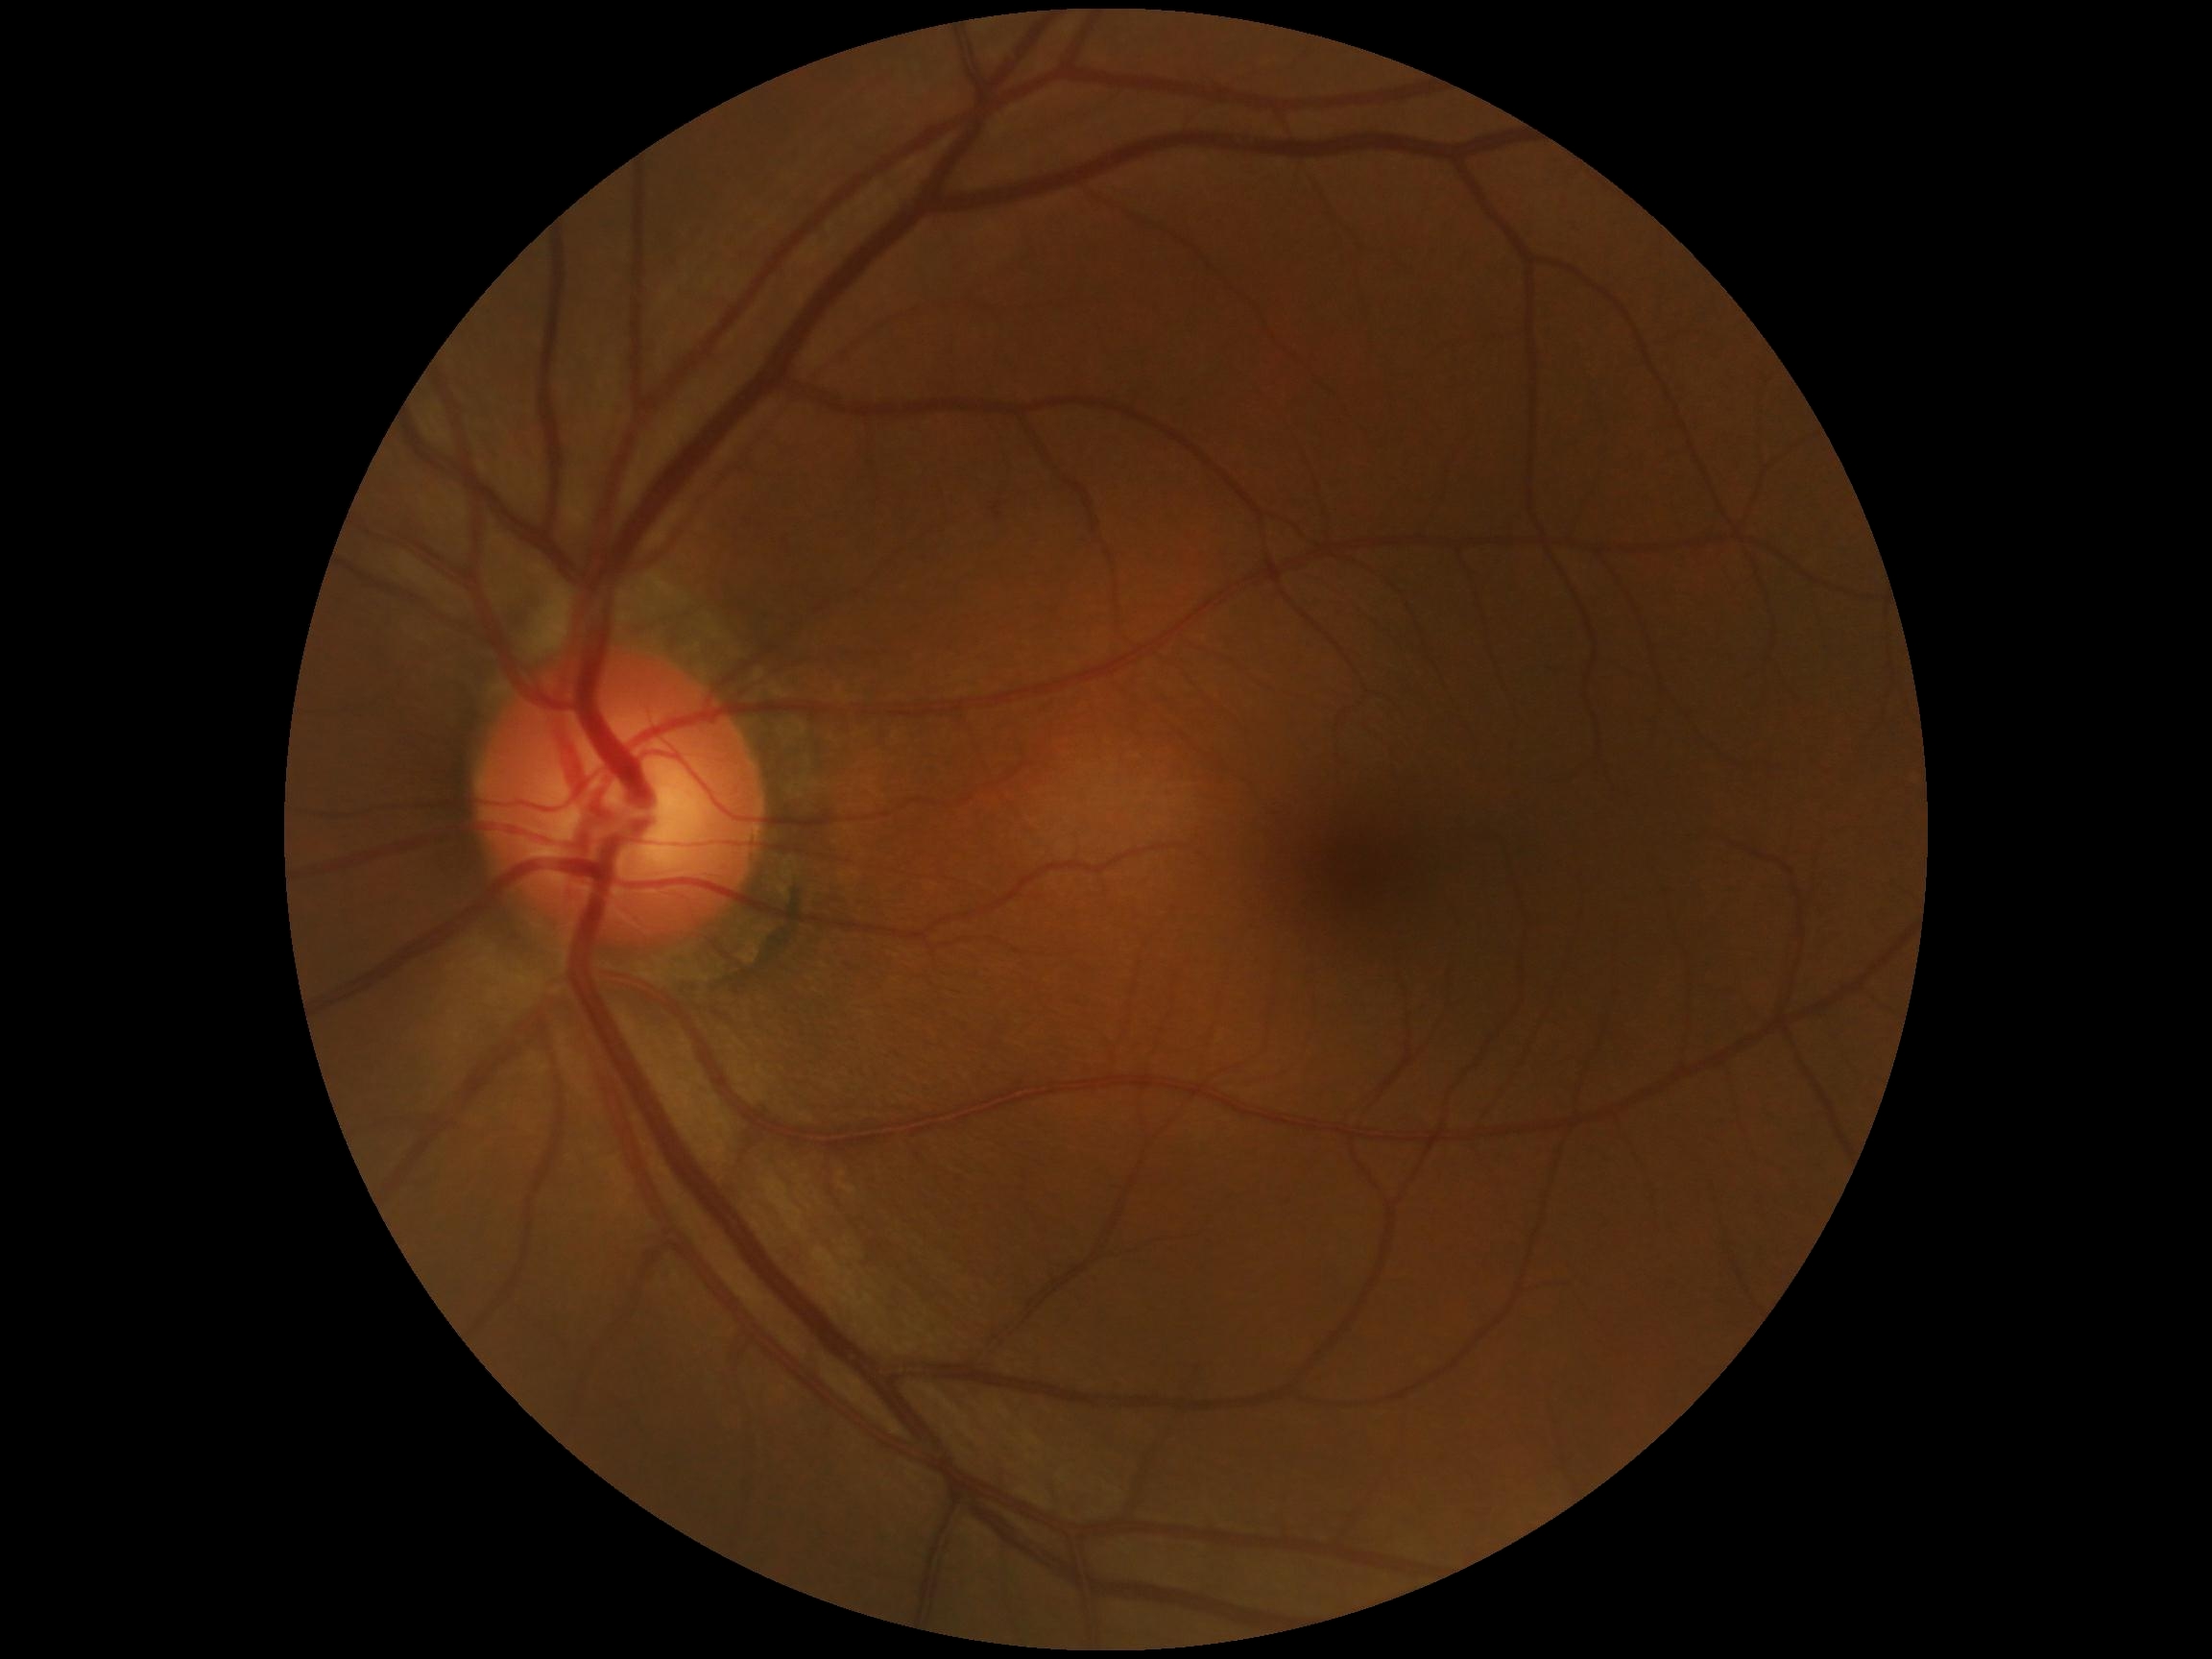

* diabetic retinopathy grade: 0/4
* DR impression: no DR findings